2352x1568px
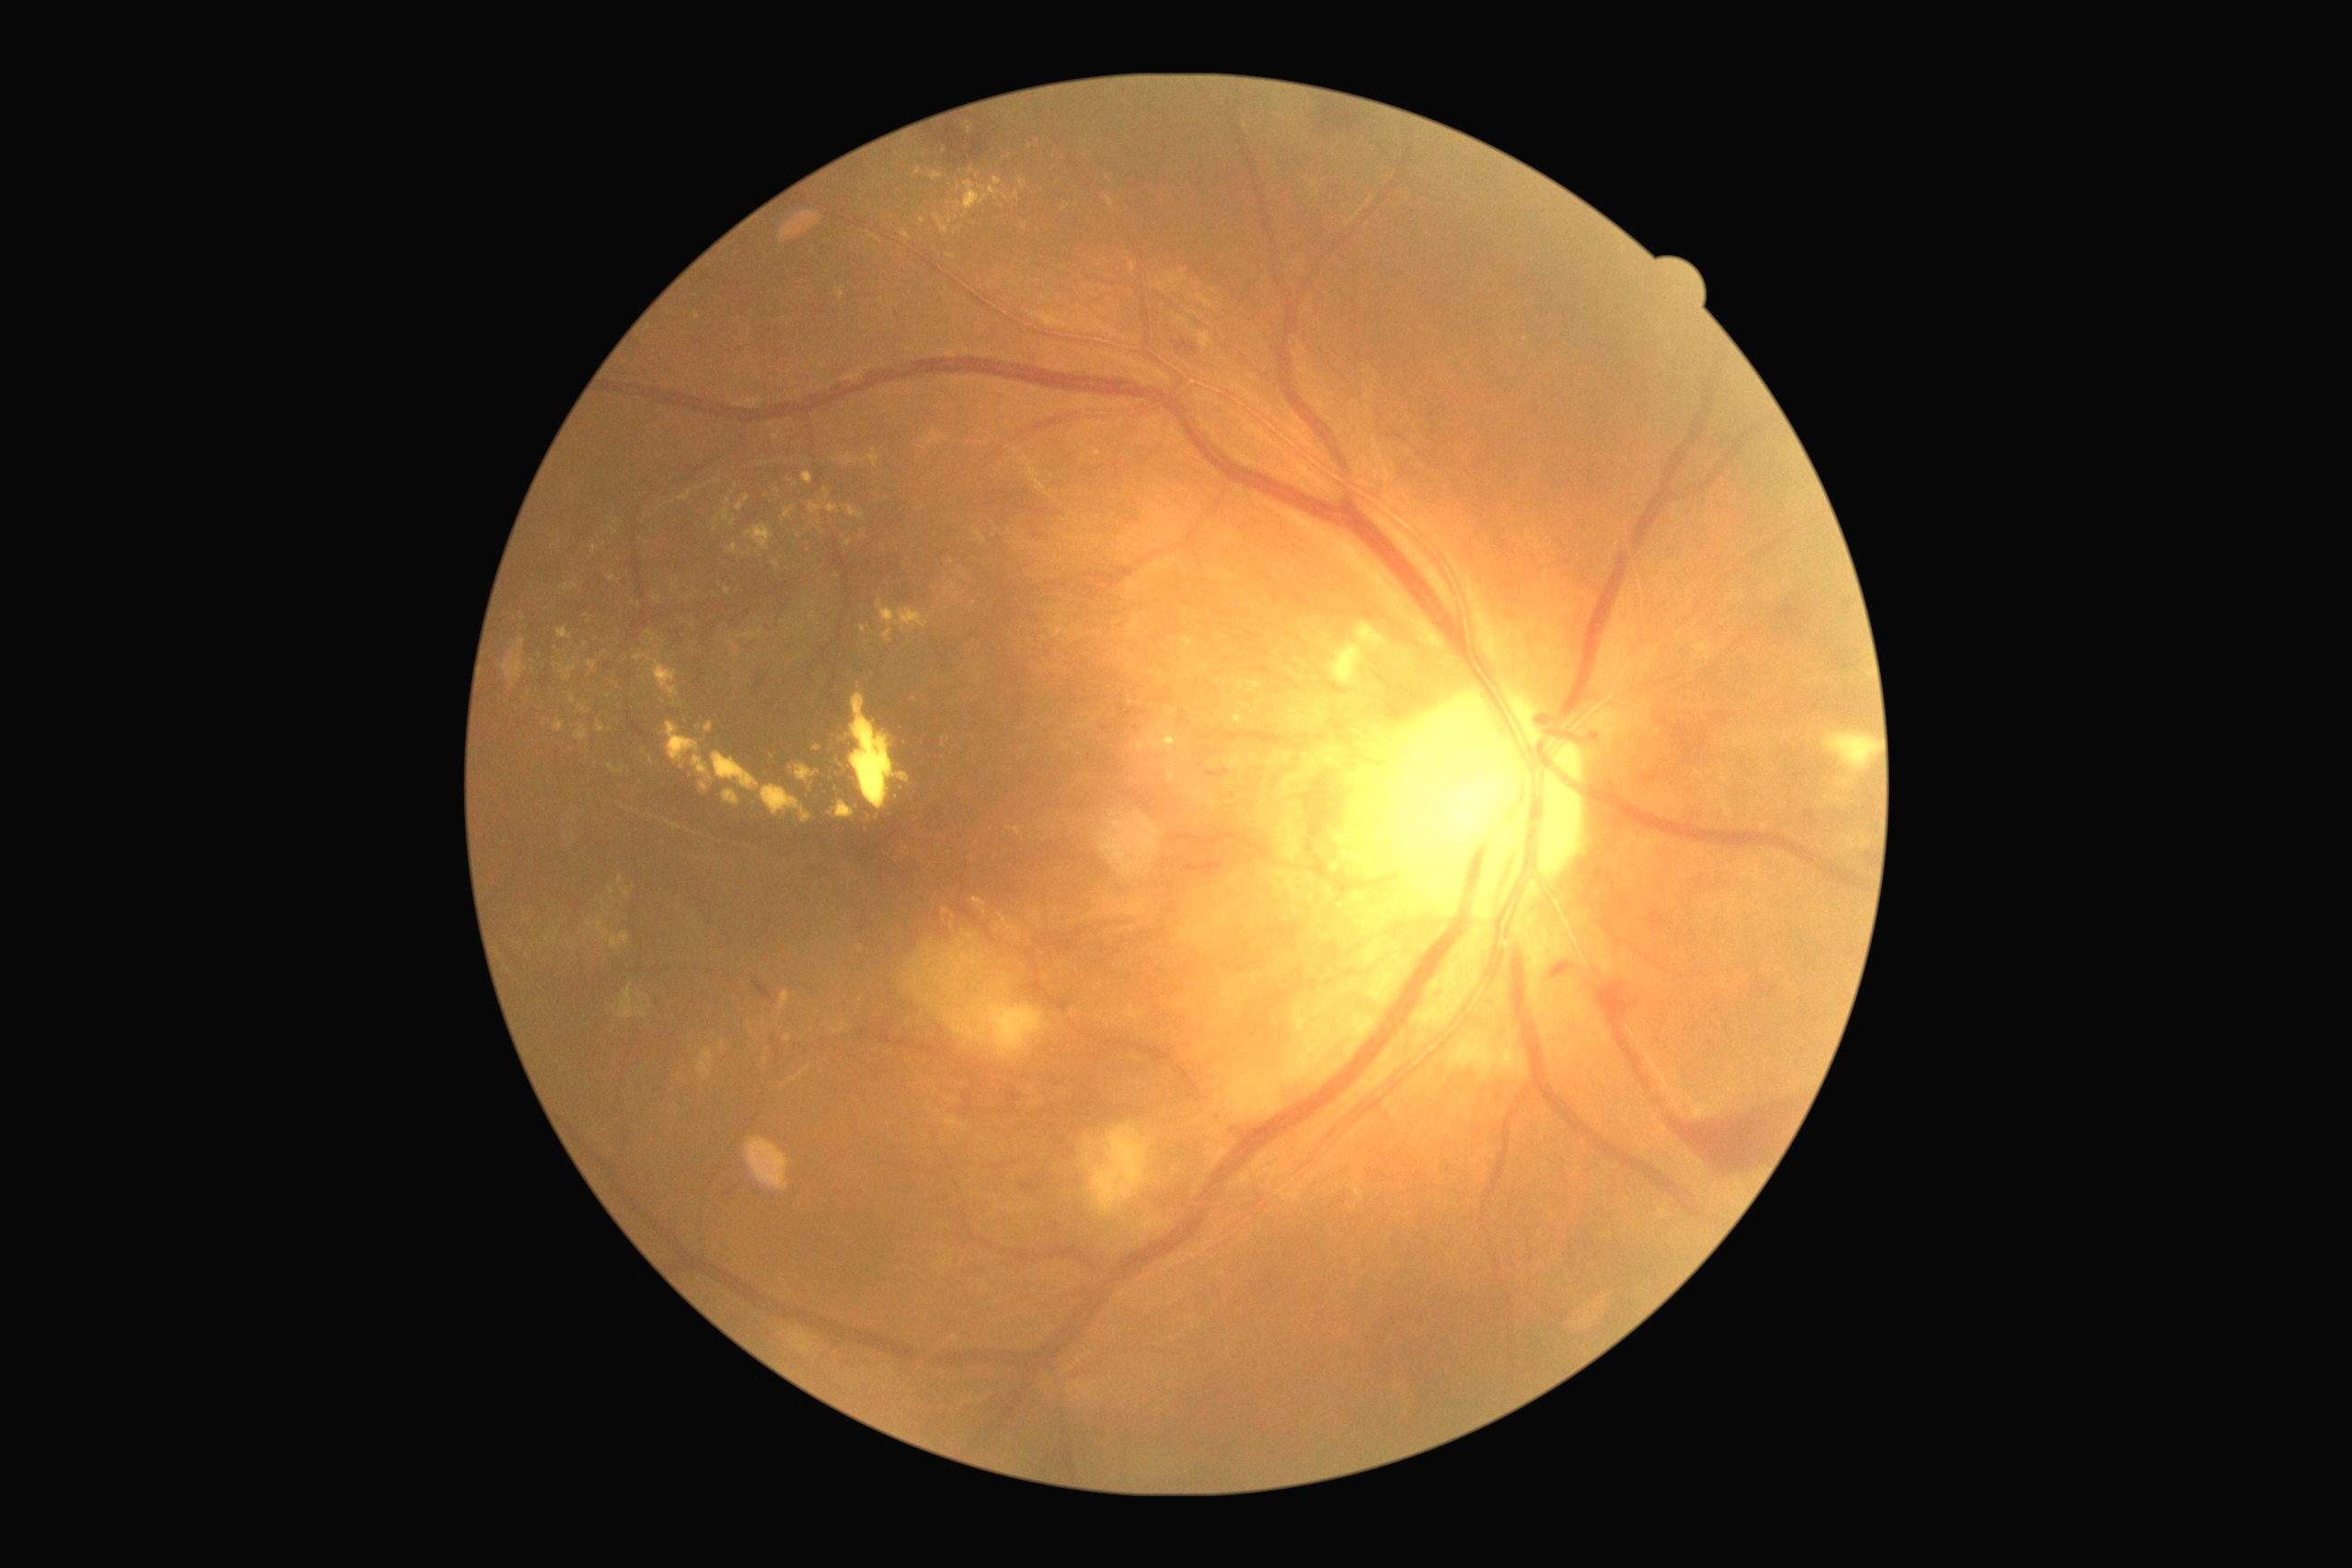
Retinopathy grade: 4. Hard exudates include those at [left=654, top=660, right=678, bottom=696], [left=1014, top=827, right=1023, bottom=836], [left=1199, top=333, right=1211, bottom=348], [left=934, top=213, right=948, bottom=233], [left=1308, top=892, right=1318, bottom=906], [left=1326, top=885, right=1335, bottom=892], [left=828, top=691, right=908, bottom=830], [left=1170, top=770, right=1175, bottom=783], [left=803, top=475, right=814, bottom=484], [left=560, top=660, right=580, bottom=681], [left=554, top=720, right=564, bottom=732], [left=1199, top=297, right=1215, bottom=309], [left=968, top=166, right=974, bottom=175]. Smaller hard exudates around (609; 696), (1183; 272), (651; 762), (950; 218), (837; 576), (959; 188). Microaneurysms identified at [left=1803, top=812, right=1818, bottom=823], [left=1032, top=533, right=1044, bottom=540], [left=1206, top=770, right=1231, bottom=778], [left=1589, top=732, right=1598, bottom=743], [left=1057, top=1137, right=1066, bottom=1142]. Smaller microaneurysms around (1069; 1151), (1868; 857). Soft exudates include those at [left=1449, top=1032, right=1527, bottom=1079], [left=983, top=1004, right=1050, bottom=1059], [left=614, top=983, right=647, bottom=1019], [left=1823, top=734, right=1876, bottom=772], [left=1415, top=1001, right=1465, bottom=1030], [left=696, top=1050, right=716, bottom=1081], [left=1333, top=645, right=1360, bottom=685], [left=1090, top=1124, right=1150, bottom=1213], [left=787, top=1329, right=814, bottom=1355], [left=1358, top=625, right=1382, bottom=645], [left=1284, top=1014, right=1377, bottom=1086]. Hemorrhages identified at [left=1660, top=714, right=1721, bottom=760], [left=1551, top=963, right=1571, bottom=981], [left=1754, top=975, right=1776, bottom=999], [left=1019, top=1184, right=1037, bottom=1193], [left=754, top=981, right=774, bottom=1003], [left=1663, top=1101, right=1798, bottom=1179], [left=1596, top=983, right=1651, bottom=1092], [left=1184, top=861, right=1224, bottom=877], [left=1173, top=340, right=1199, bottom=358], [left=926, top=112, right=1003, bottom=170].